DR severity per modified Davis staging, 45° field of view, camera: NIDEK AFC-230
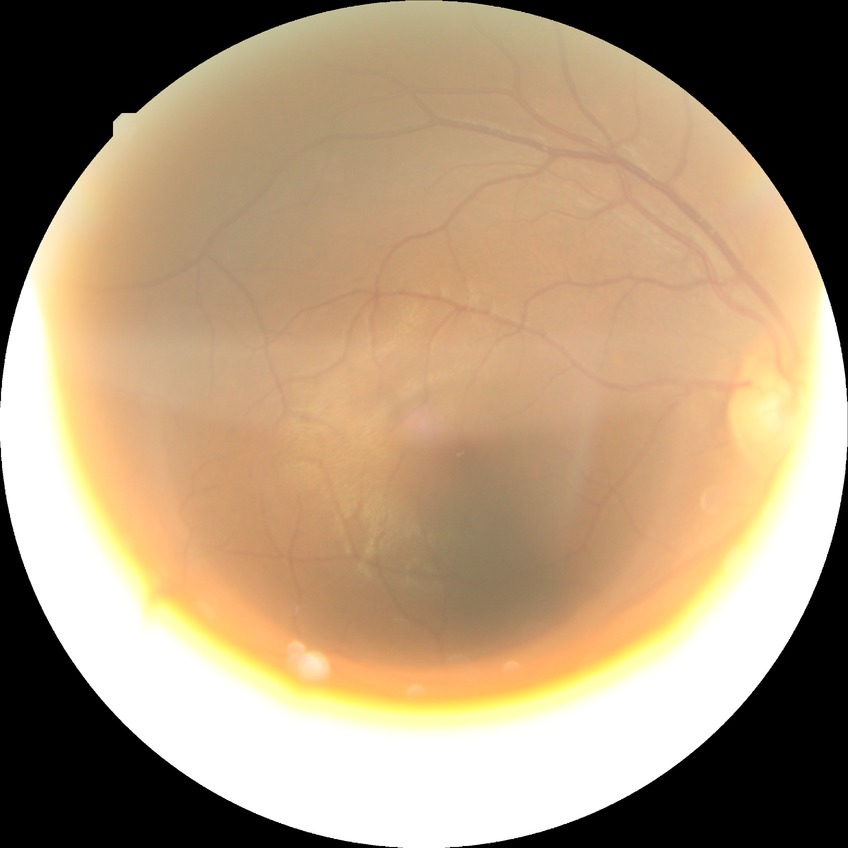
Diabetic retinopathy (DR): NDR (no diabetic retinopathy).